Camera: NIDEK AFC-230:
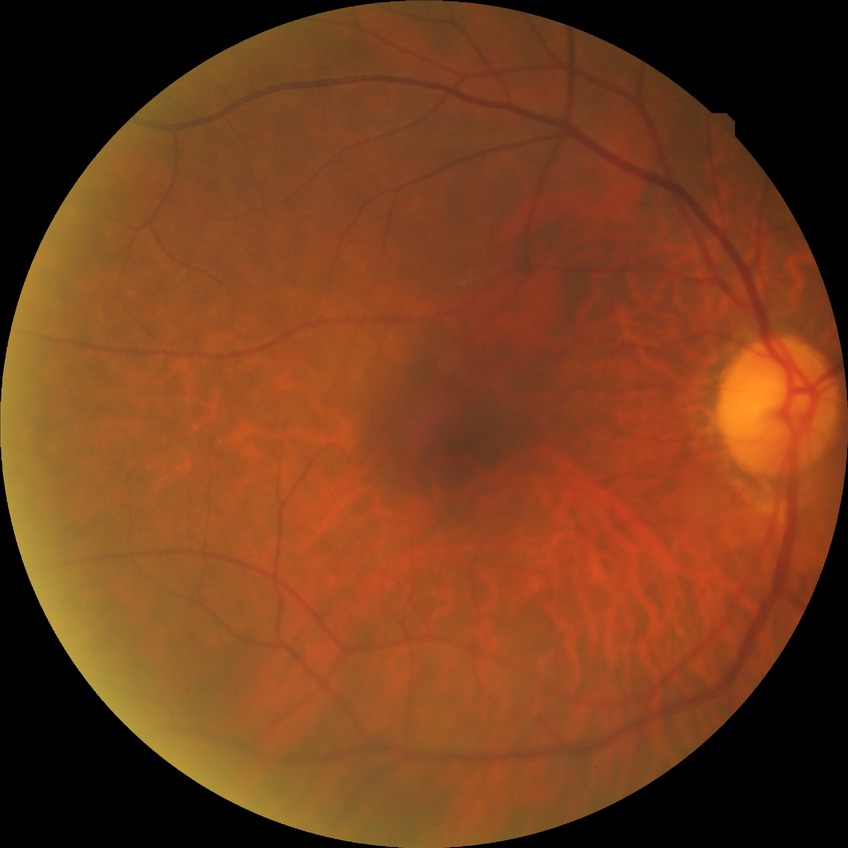 DR grade is NDR.